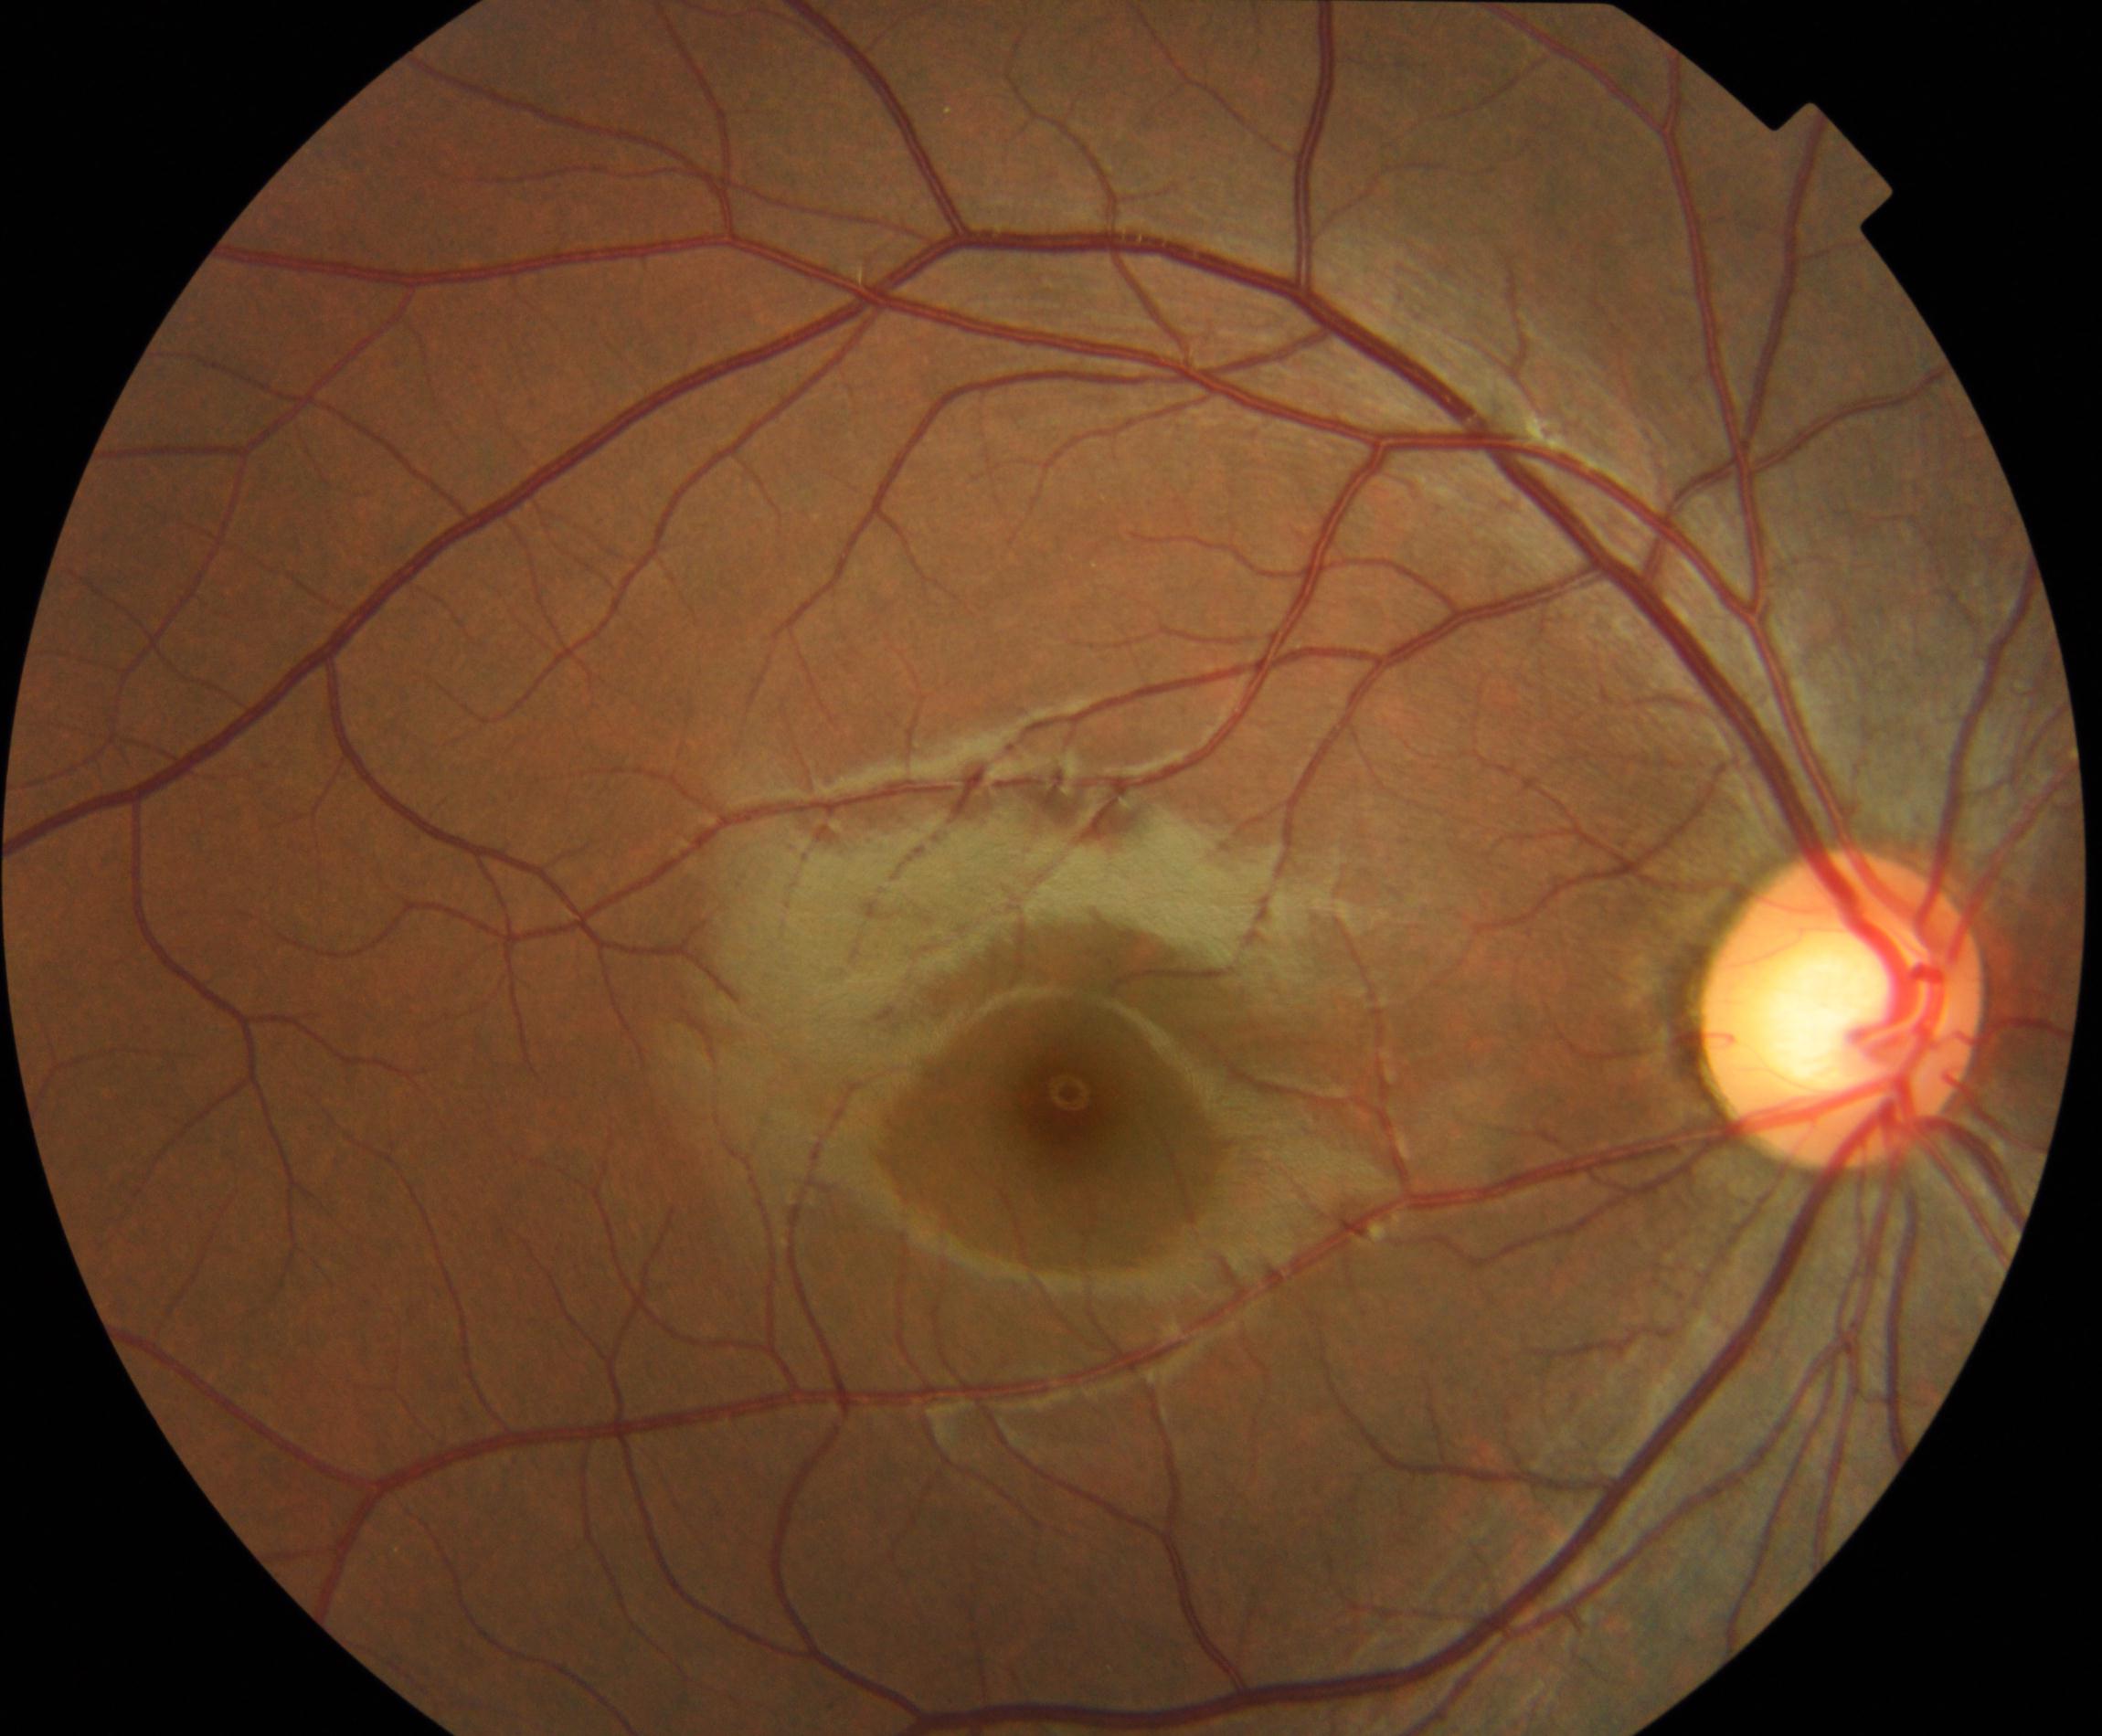 Diagnosis: large optic cup.